2352x1568px. CFP. 45° FOV.
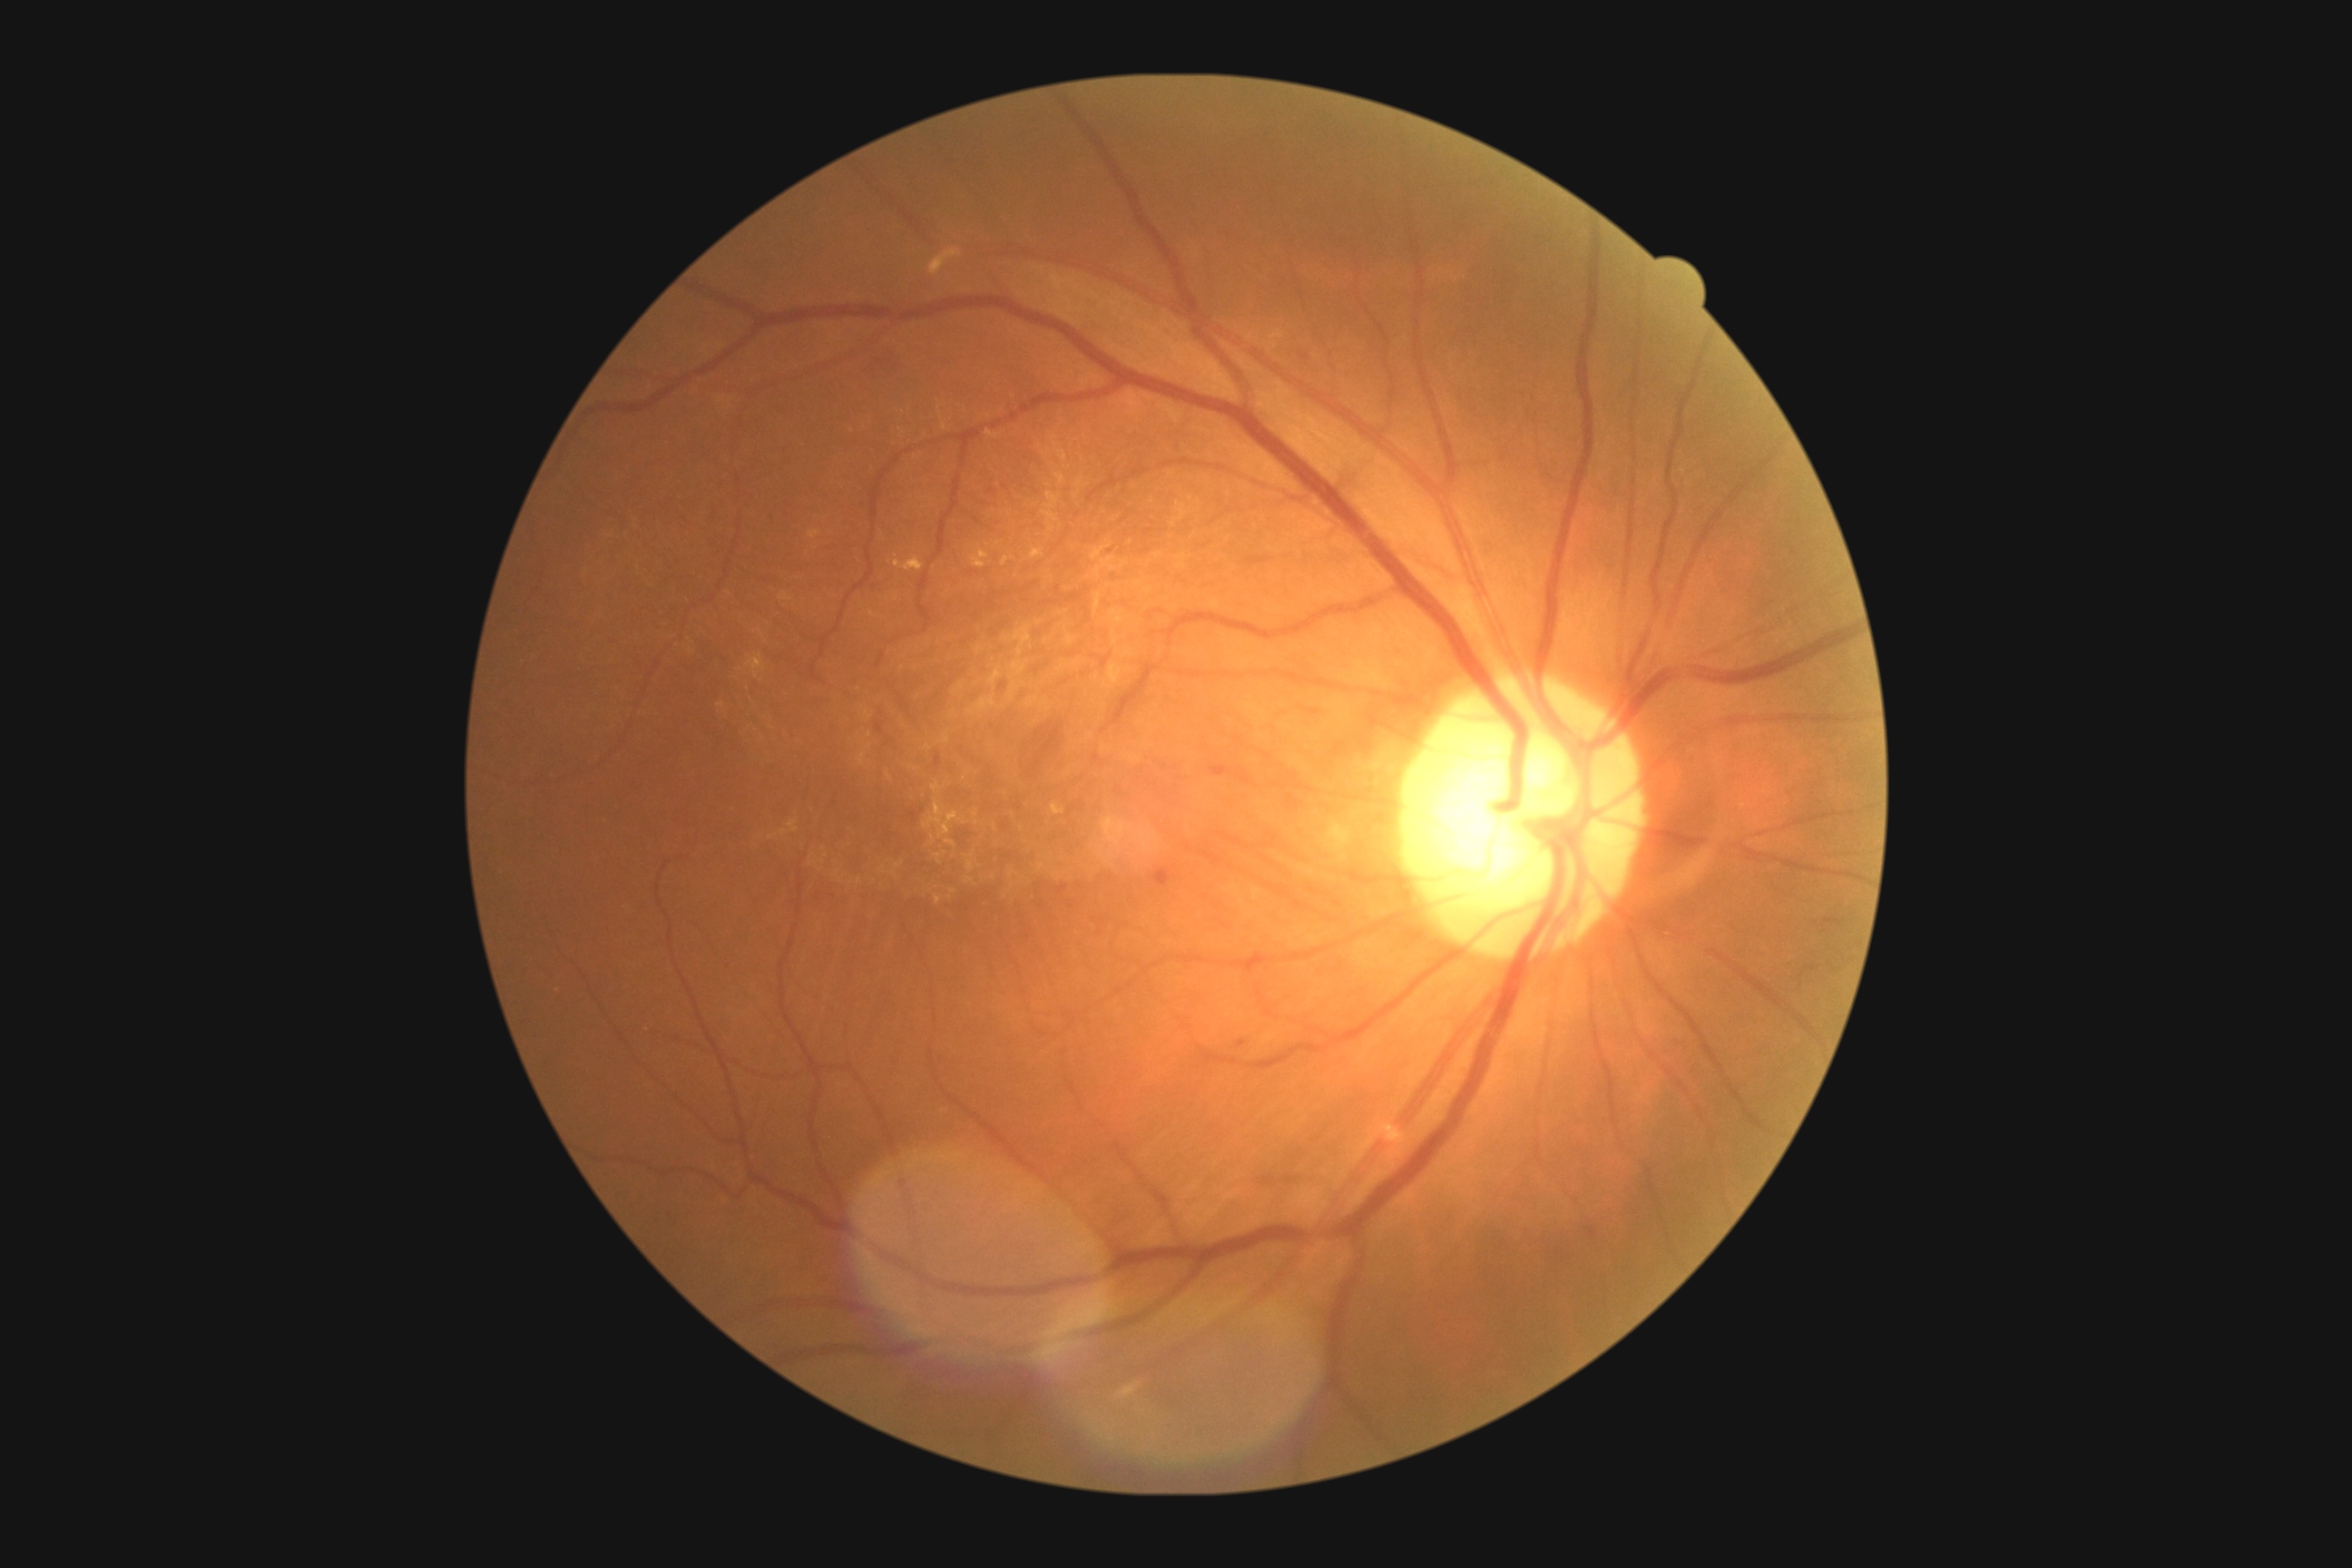
<lesions partial="true">
  <dr_grade>2</dr_grade>
  <ma>Rect(1211, 765, 1233, 778) | Rect(1153, 868, 1171, 887) | Rect(1237, 1041, 1248, 1050)</ma>
  <ex partial="true">Rect(1052, 803, 1064, 816) | Rect(932, 783, 943, 794) | Rect(945, 839, 957, 848) | Rect(894, 556, 925, 573) | Rect(925, 801, 966, 838) | Rect(1003, 556, 1014, 567) | Rect(930, 836, 936, 845) | Rect(1119, 1384, 1141, 1400) | Rect(934, 854, 943, 865) | Rect(1101, 816, 1128, 834) | Rect(972, 549, 990, 569) | Rect(1032, 549, 1044, 560) | Rect(747, 656, 767, 680)</ex>
  <ex_small_approx>(x=964, y=779) | (x=988, y=545) | (x=975, y=815)</ex_small_approx>
  <he>Rect(863, 349, 899, 384)</he>
  <se />
</lesions>